Wide-field fundus photograph of an infant. 130° field of view (Natus RetCam Envision). 1440x1080:
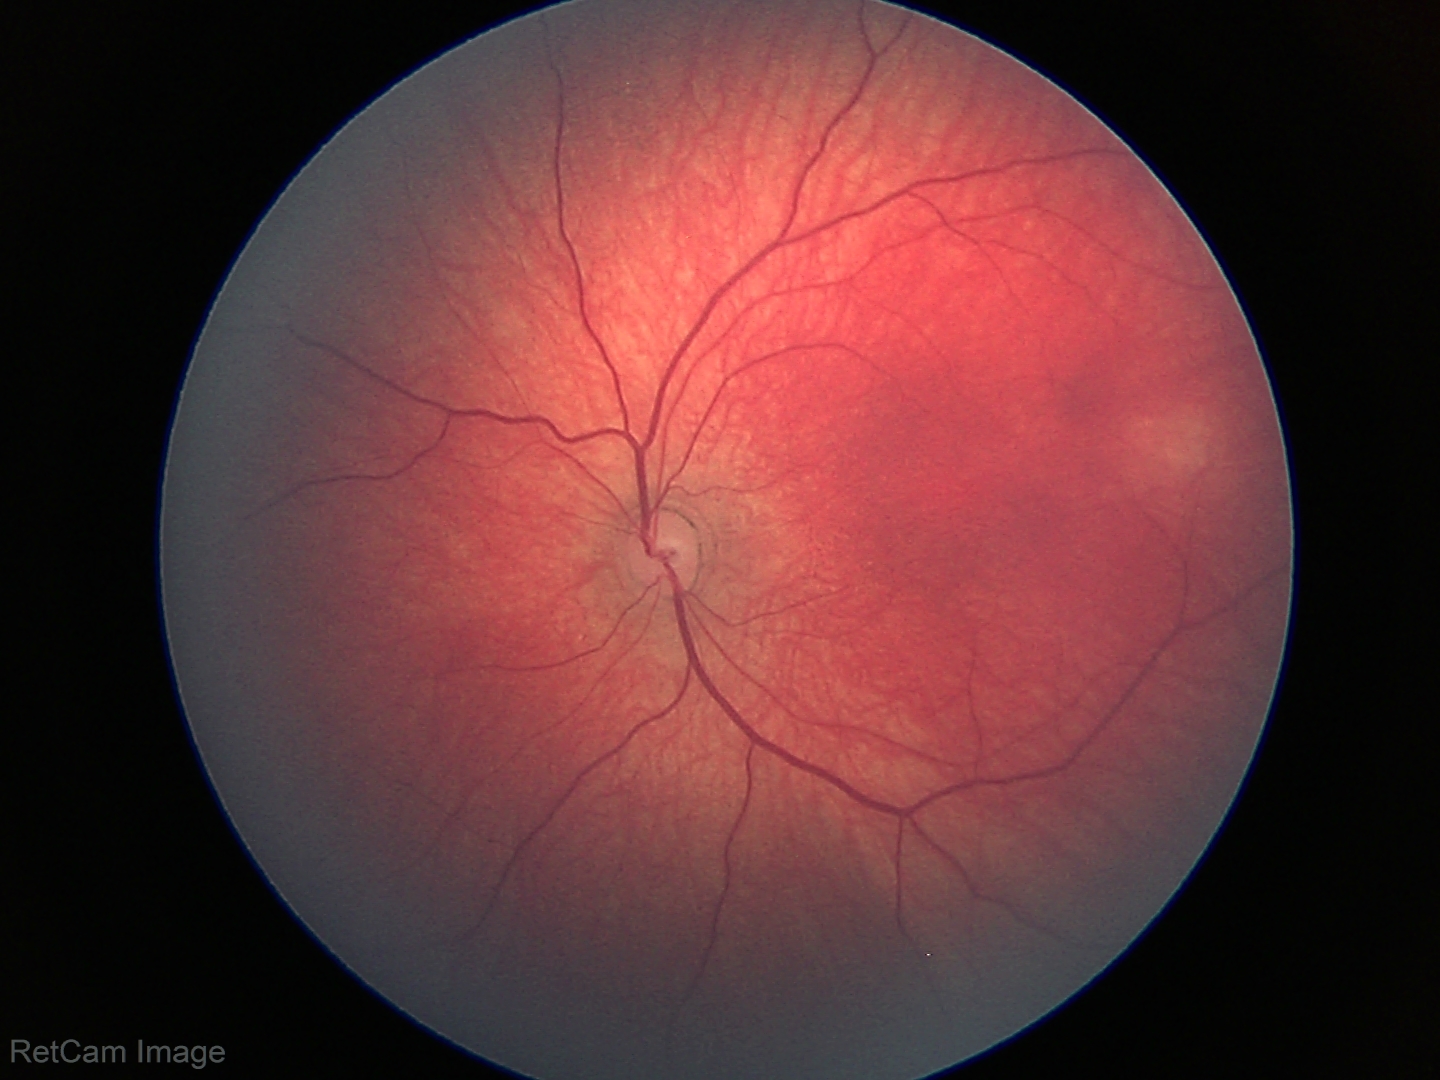

Screening: no abnormal retinal findings.